FOV: 45 degrees; image size 848x848: 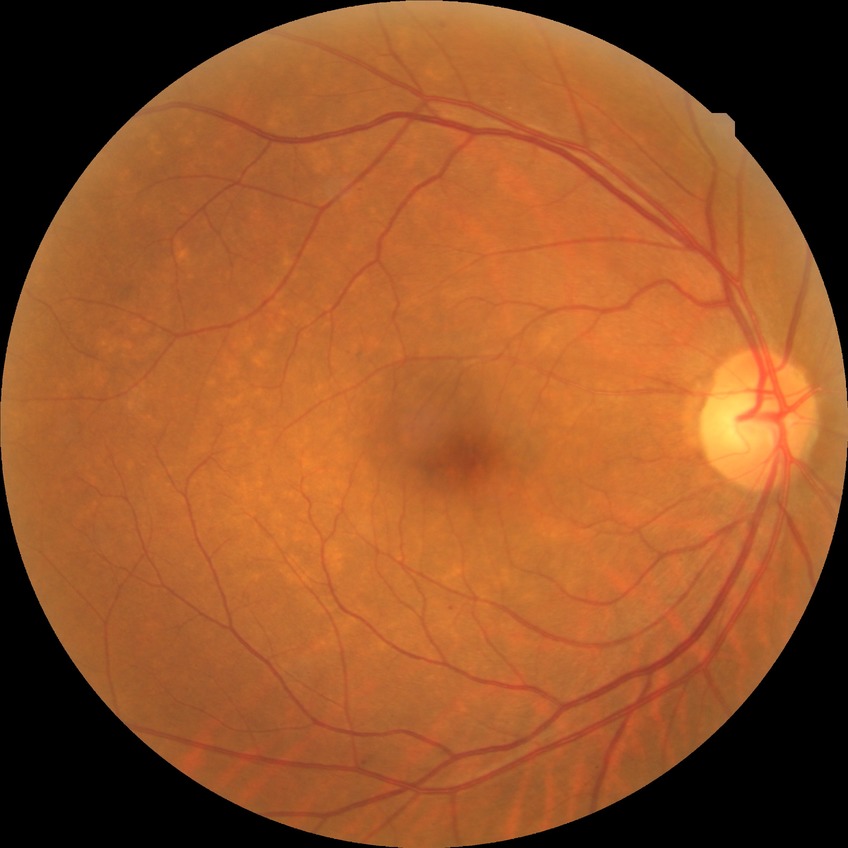 Diabetic retinopathy (DR) is SDR (simple diabetic retinopathy).